Posterior pole photograph, 848x848px — 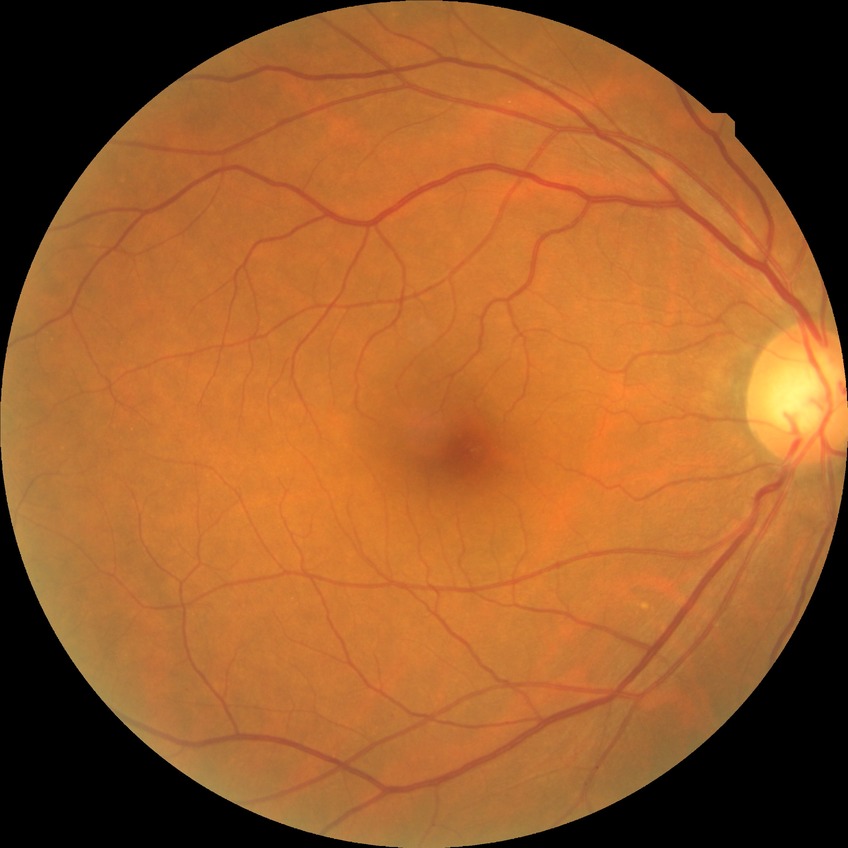 Diabetic retinopathy (DR) is simple diabetic retinopathy (SDR).